2346x1568px. 45° FOV: 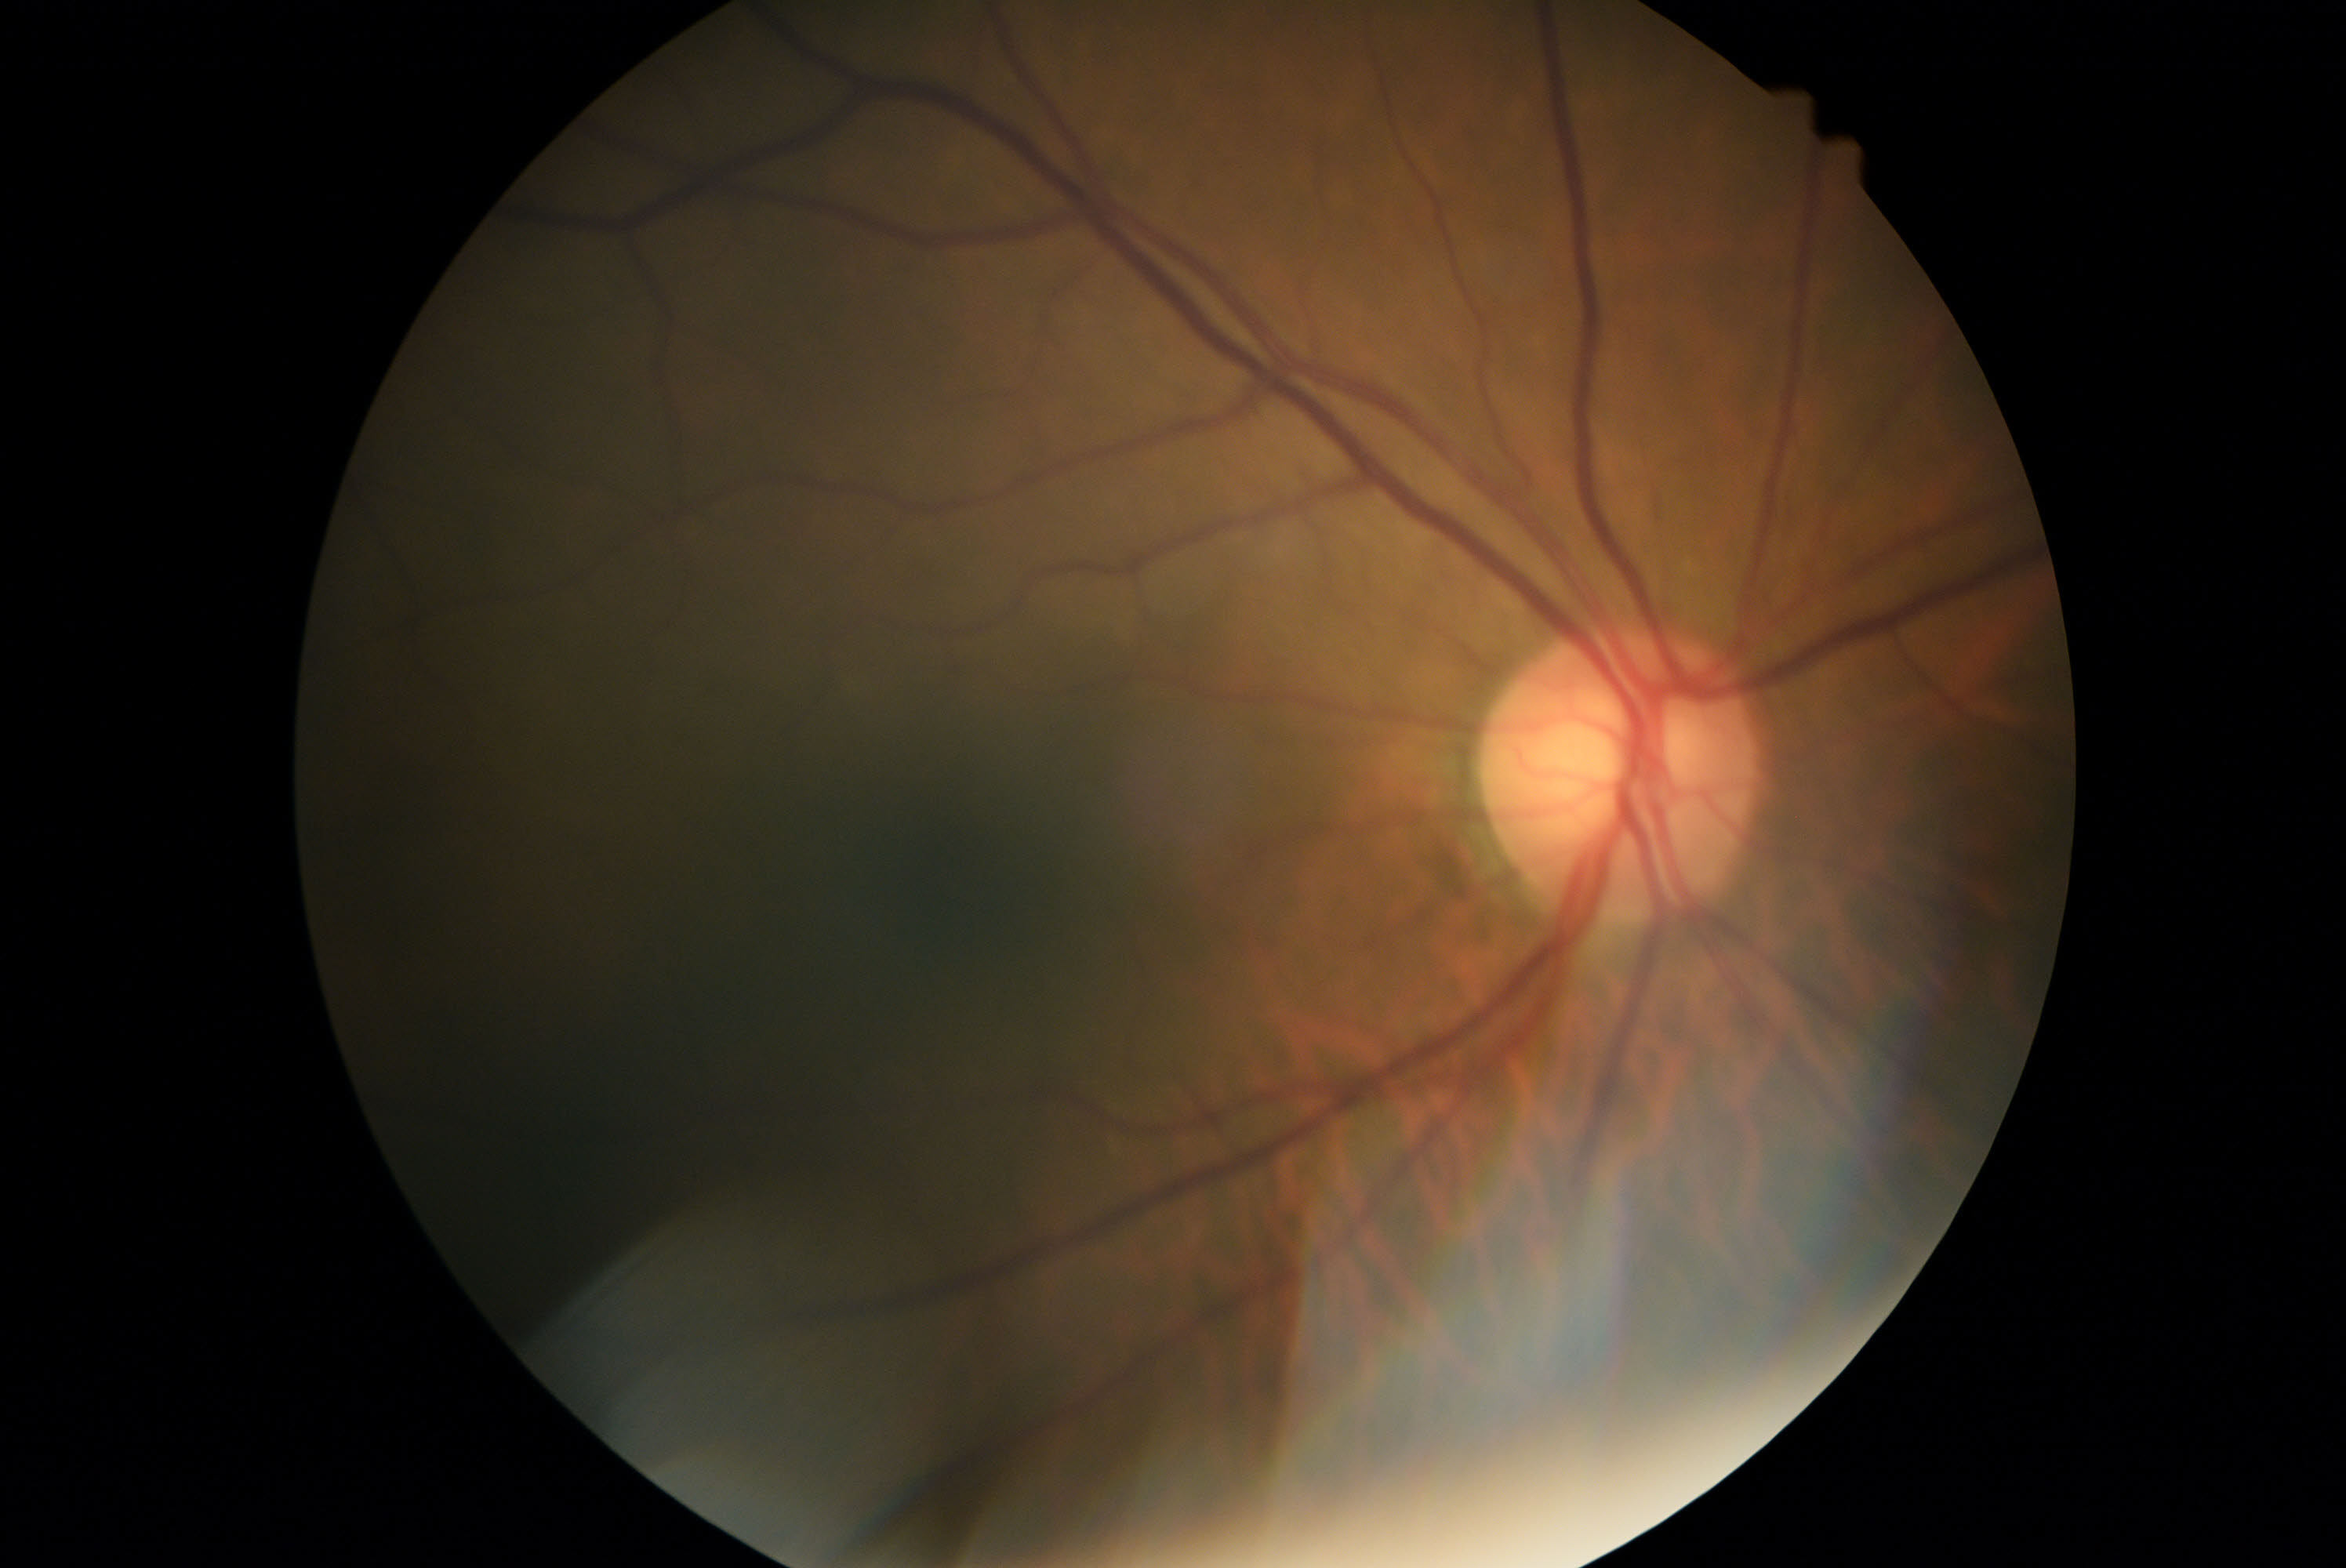 Diabetic retinopathy is 0.